Handheld portable fundus camera image. 2212x1659px:
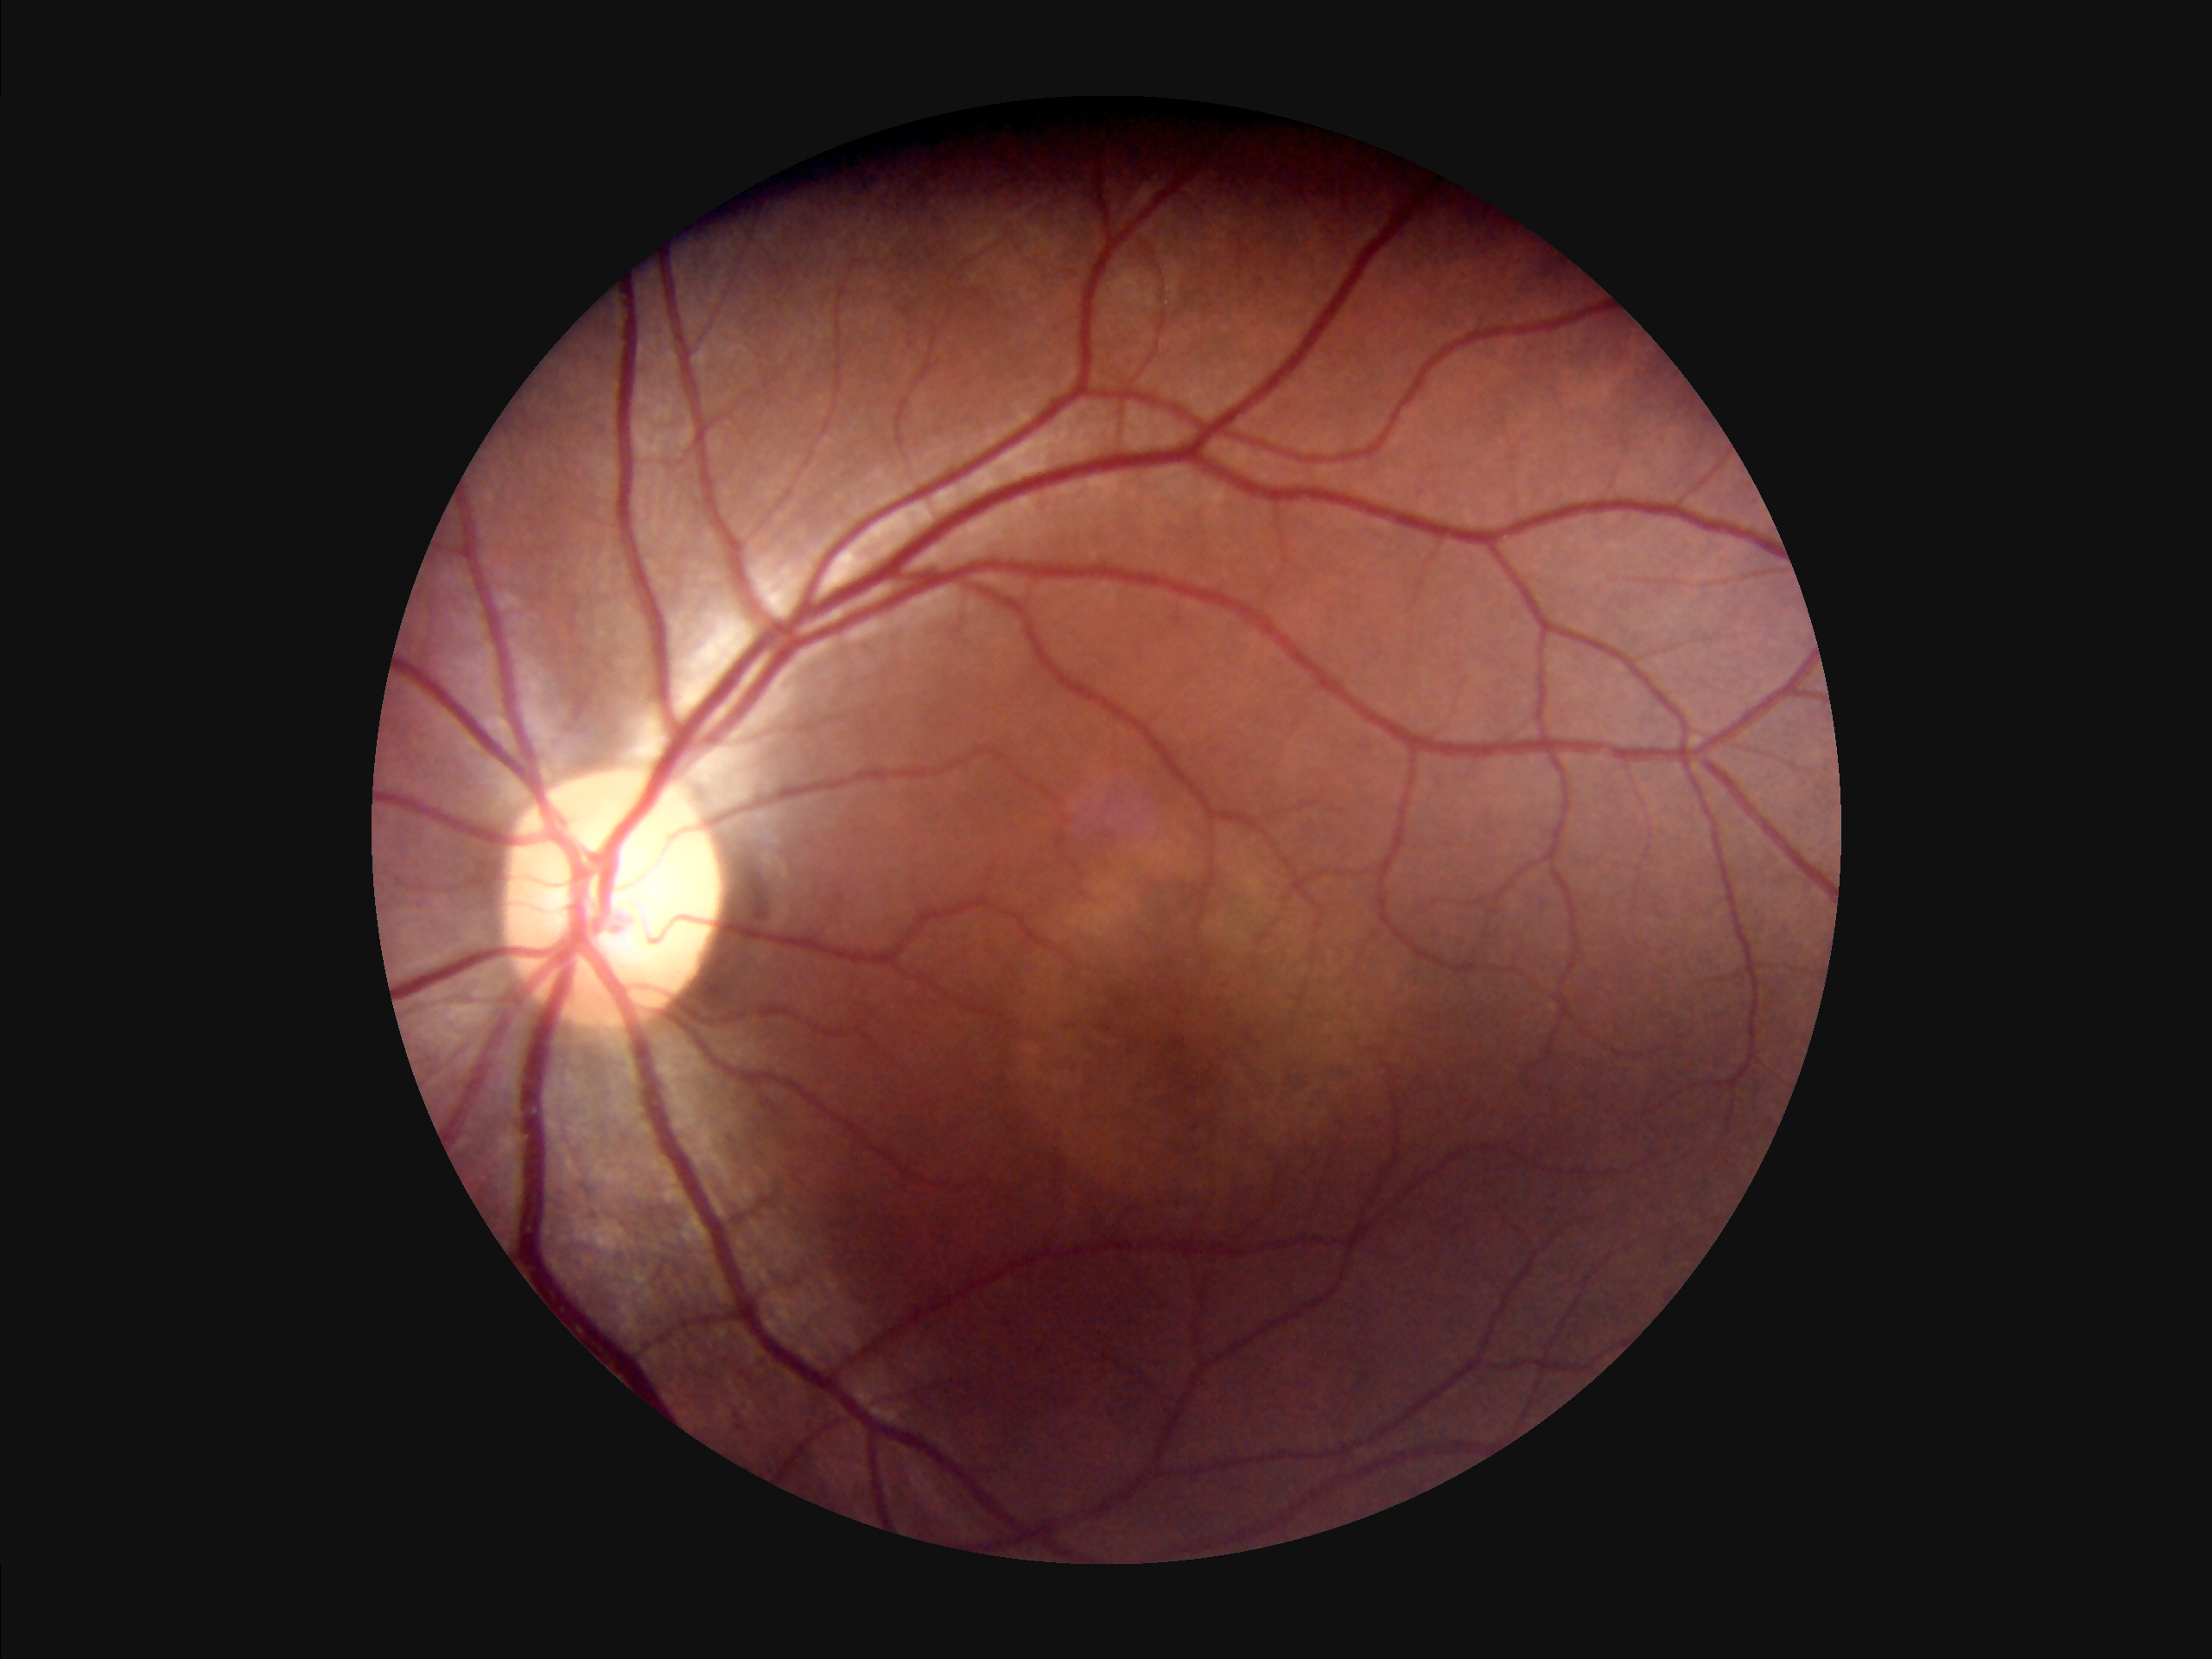 Illumination = good
Contrast = good